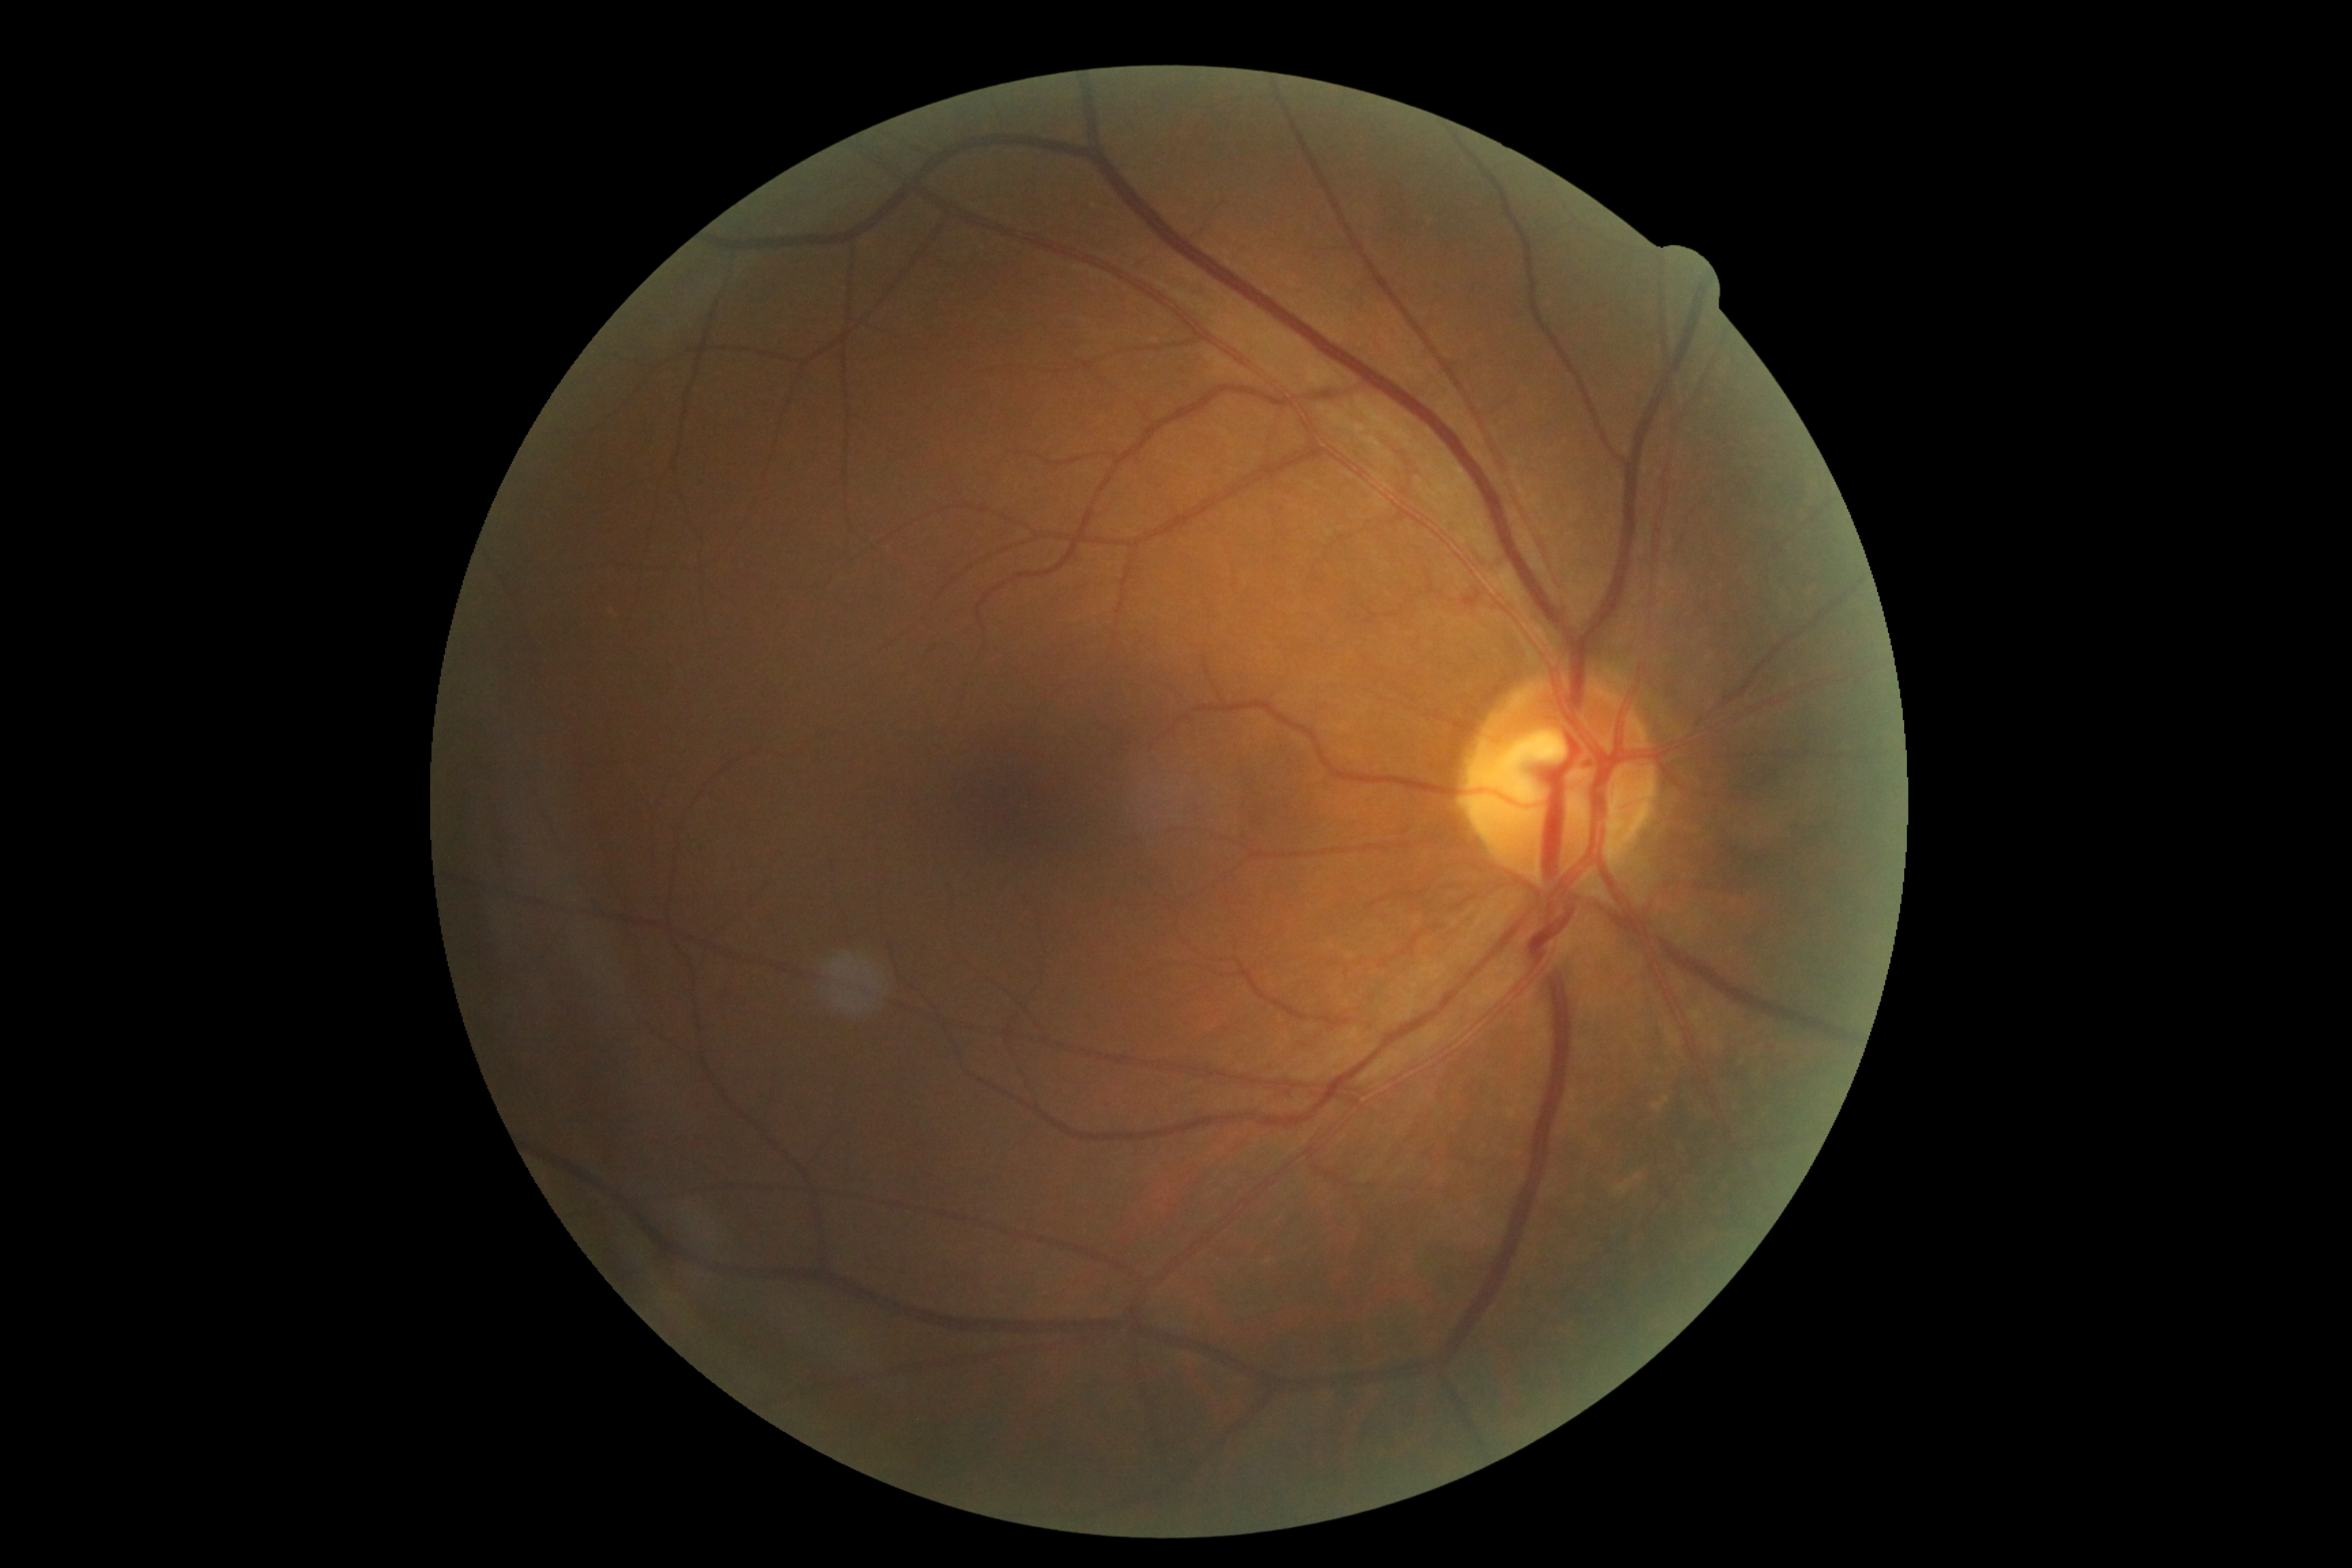
  dr_grade: no apparent retinopathy (0)
  dr_impression: no DR findings